Image size 2212x1672 · 45° FOV — 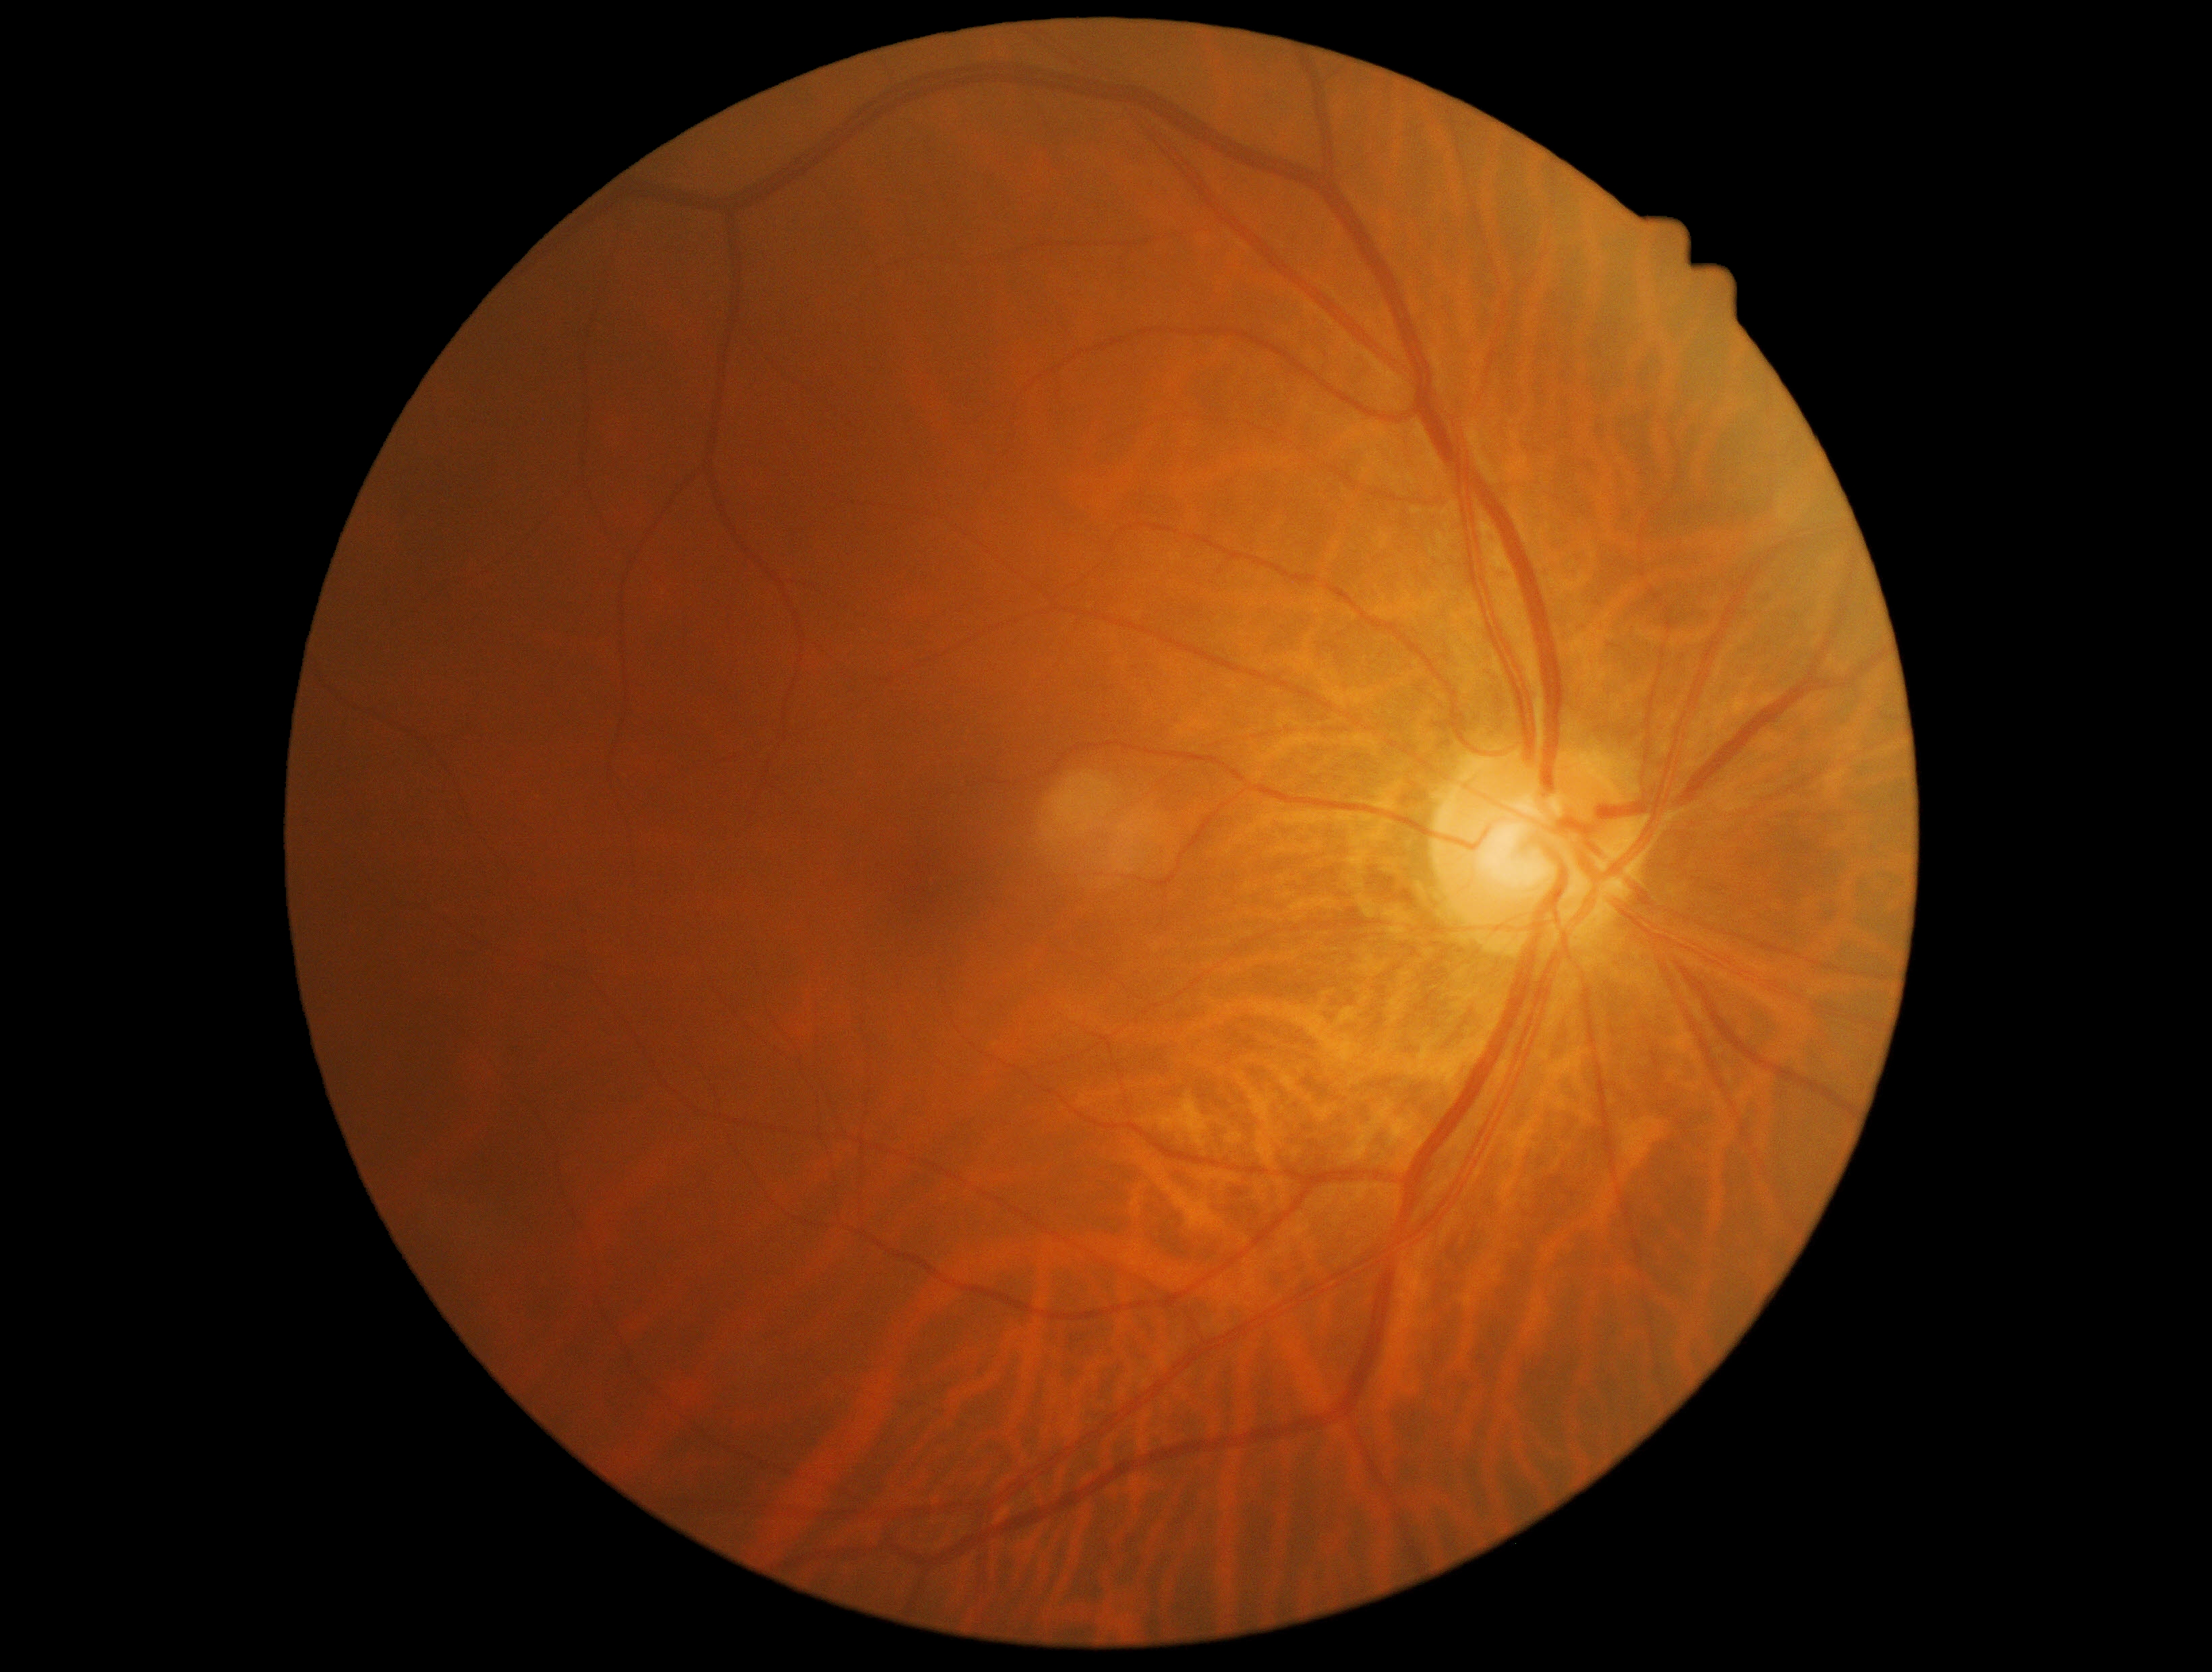
DR stage: grade 0 (no apparent retinopathy) — no visible signs of diabetic retinopathy.